45° field of view
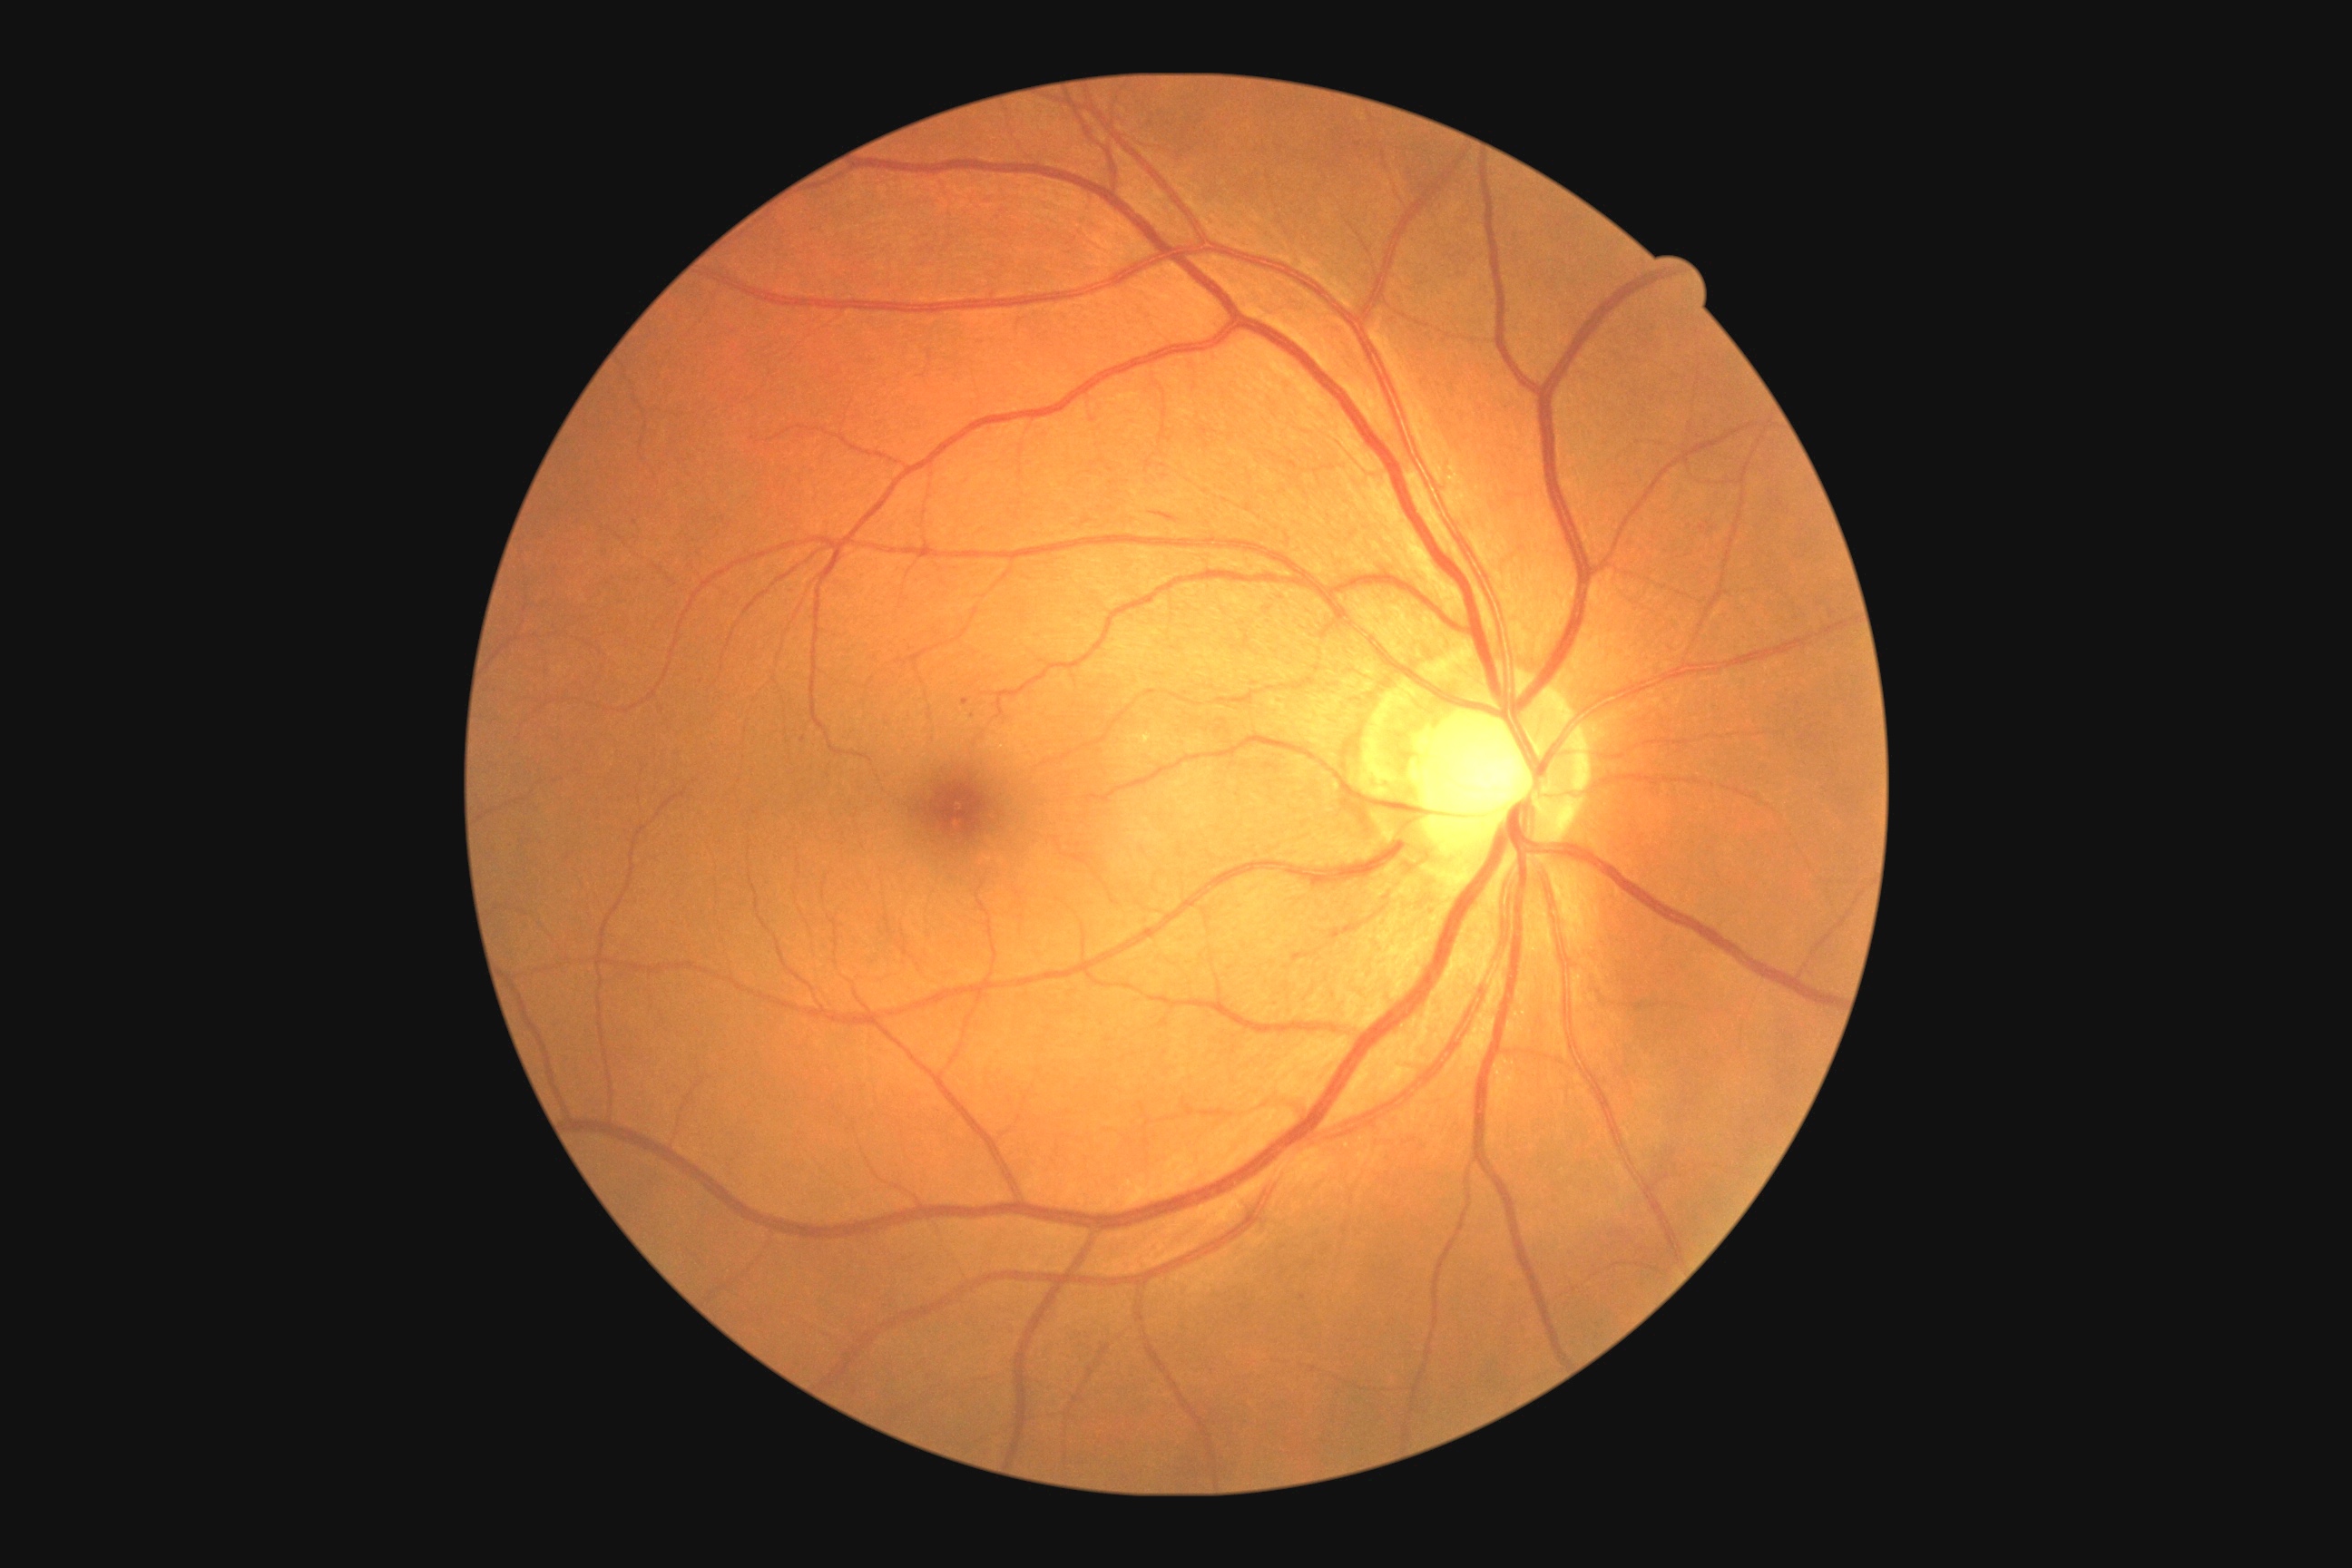

diabetic retinopathy grade@2 (moderate NPDR).